Fundus photo
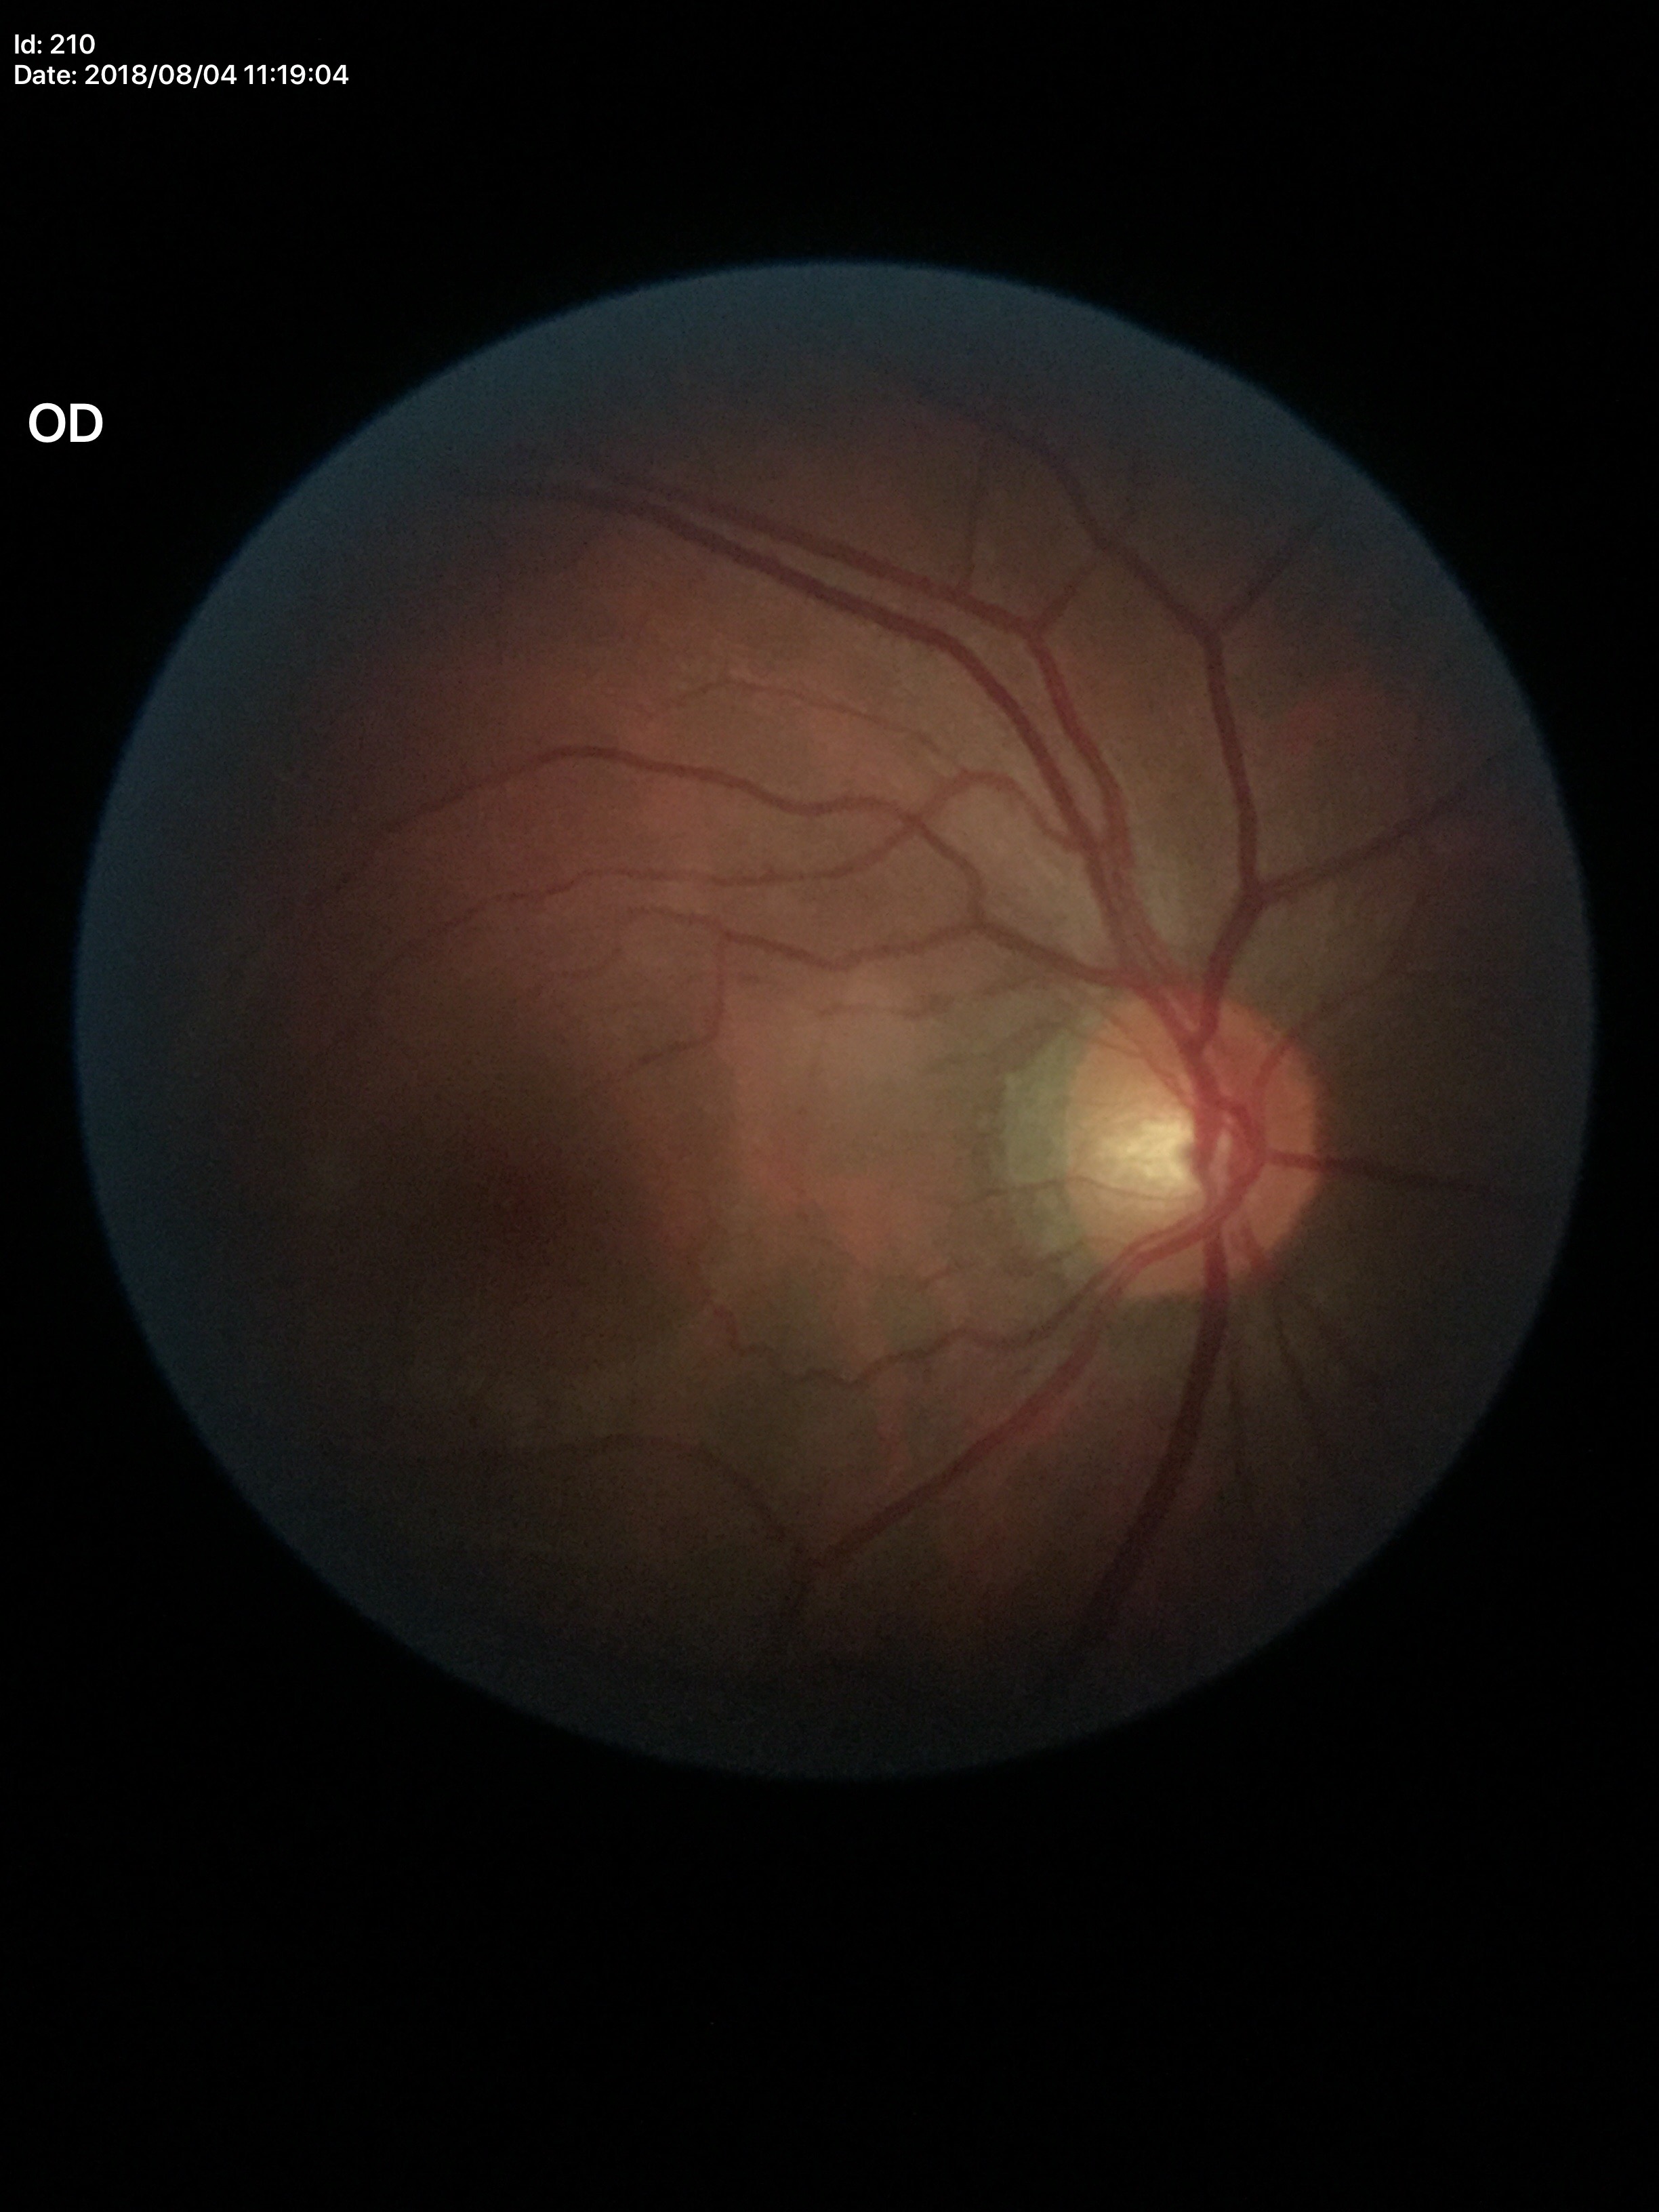

vertical C/D ratio: 0.58, Glaucoma impression: suspect (three of five ophthalmologists flagged glaucoma suspect).